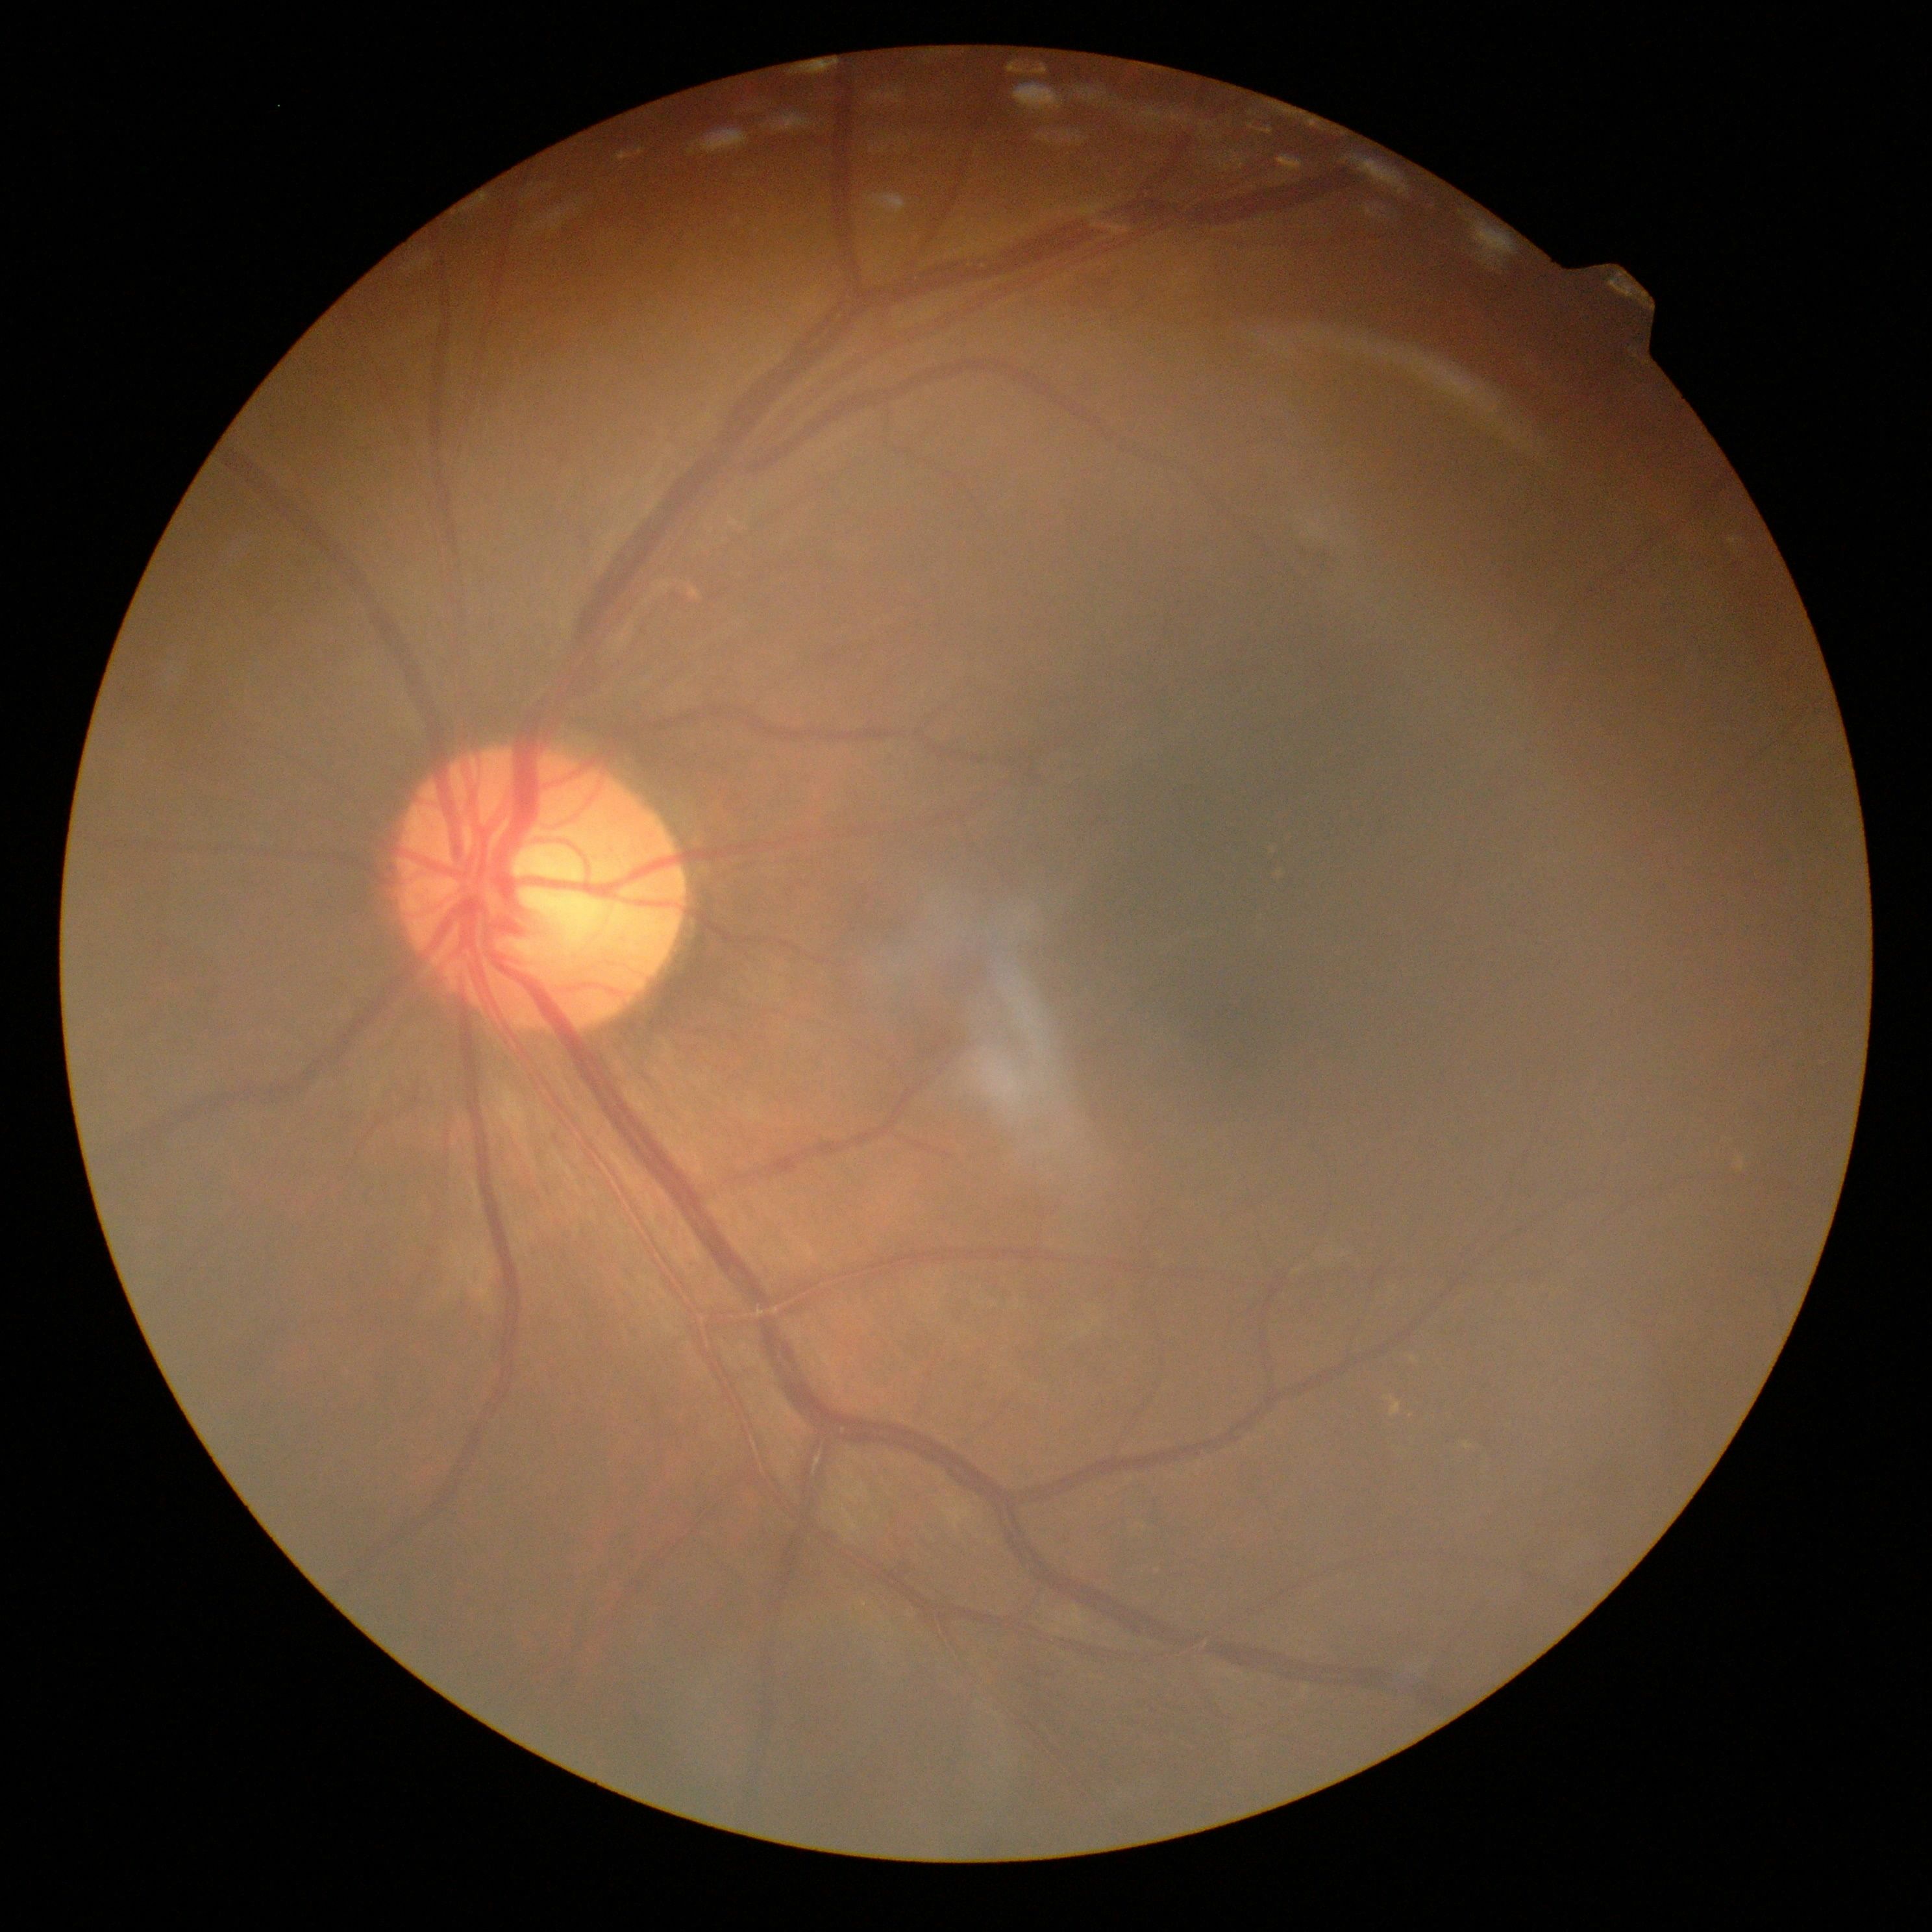

Diabetic retinopathy (DR): grade 2 (moderate NPDR) — more than just microaneurysms but less than severe NPDR.